45° field of view.
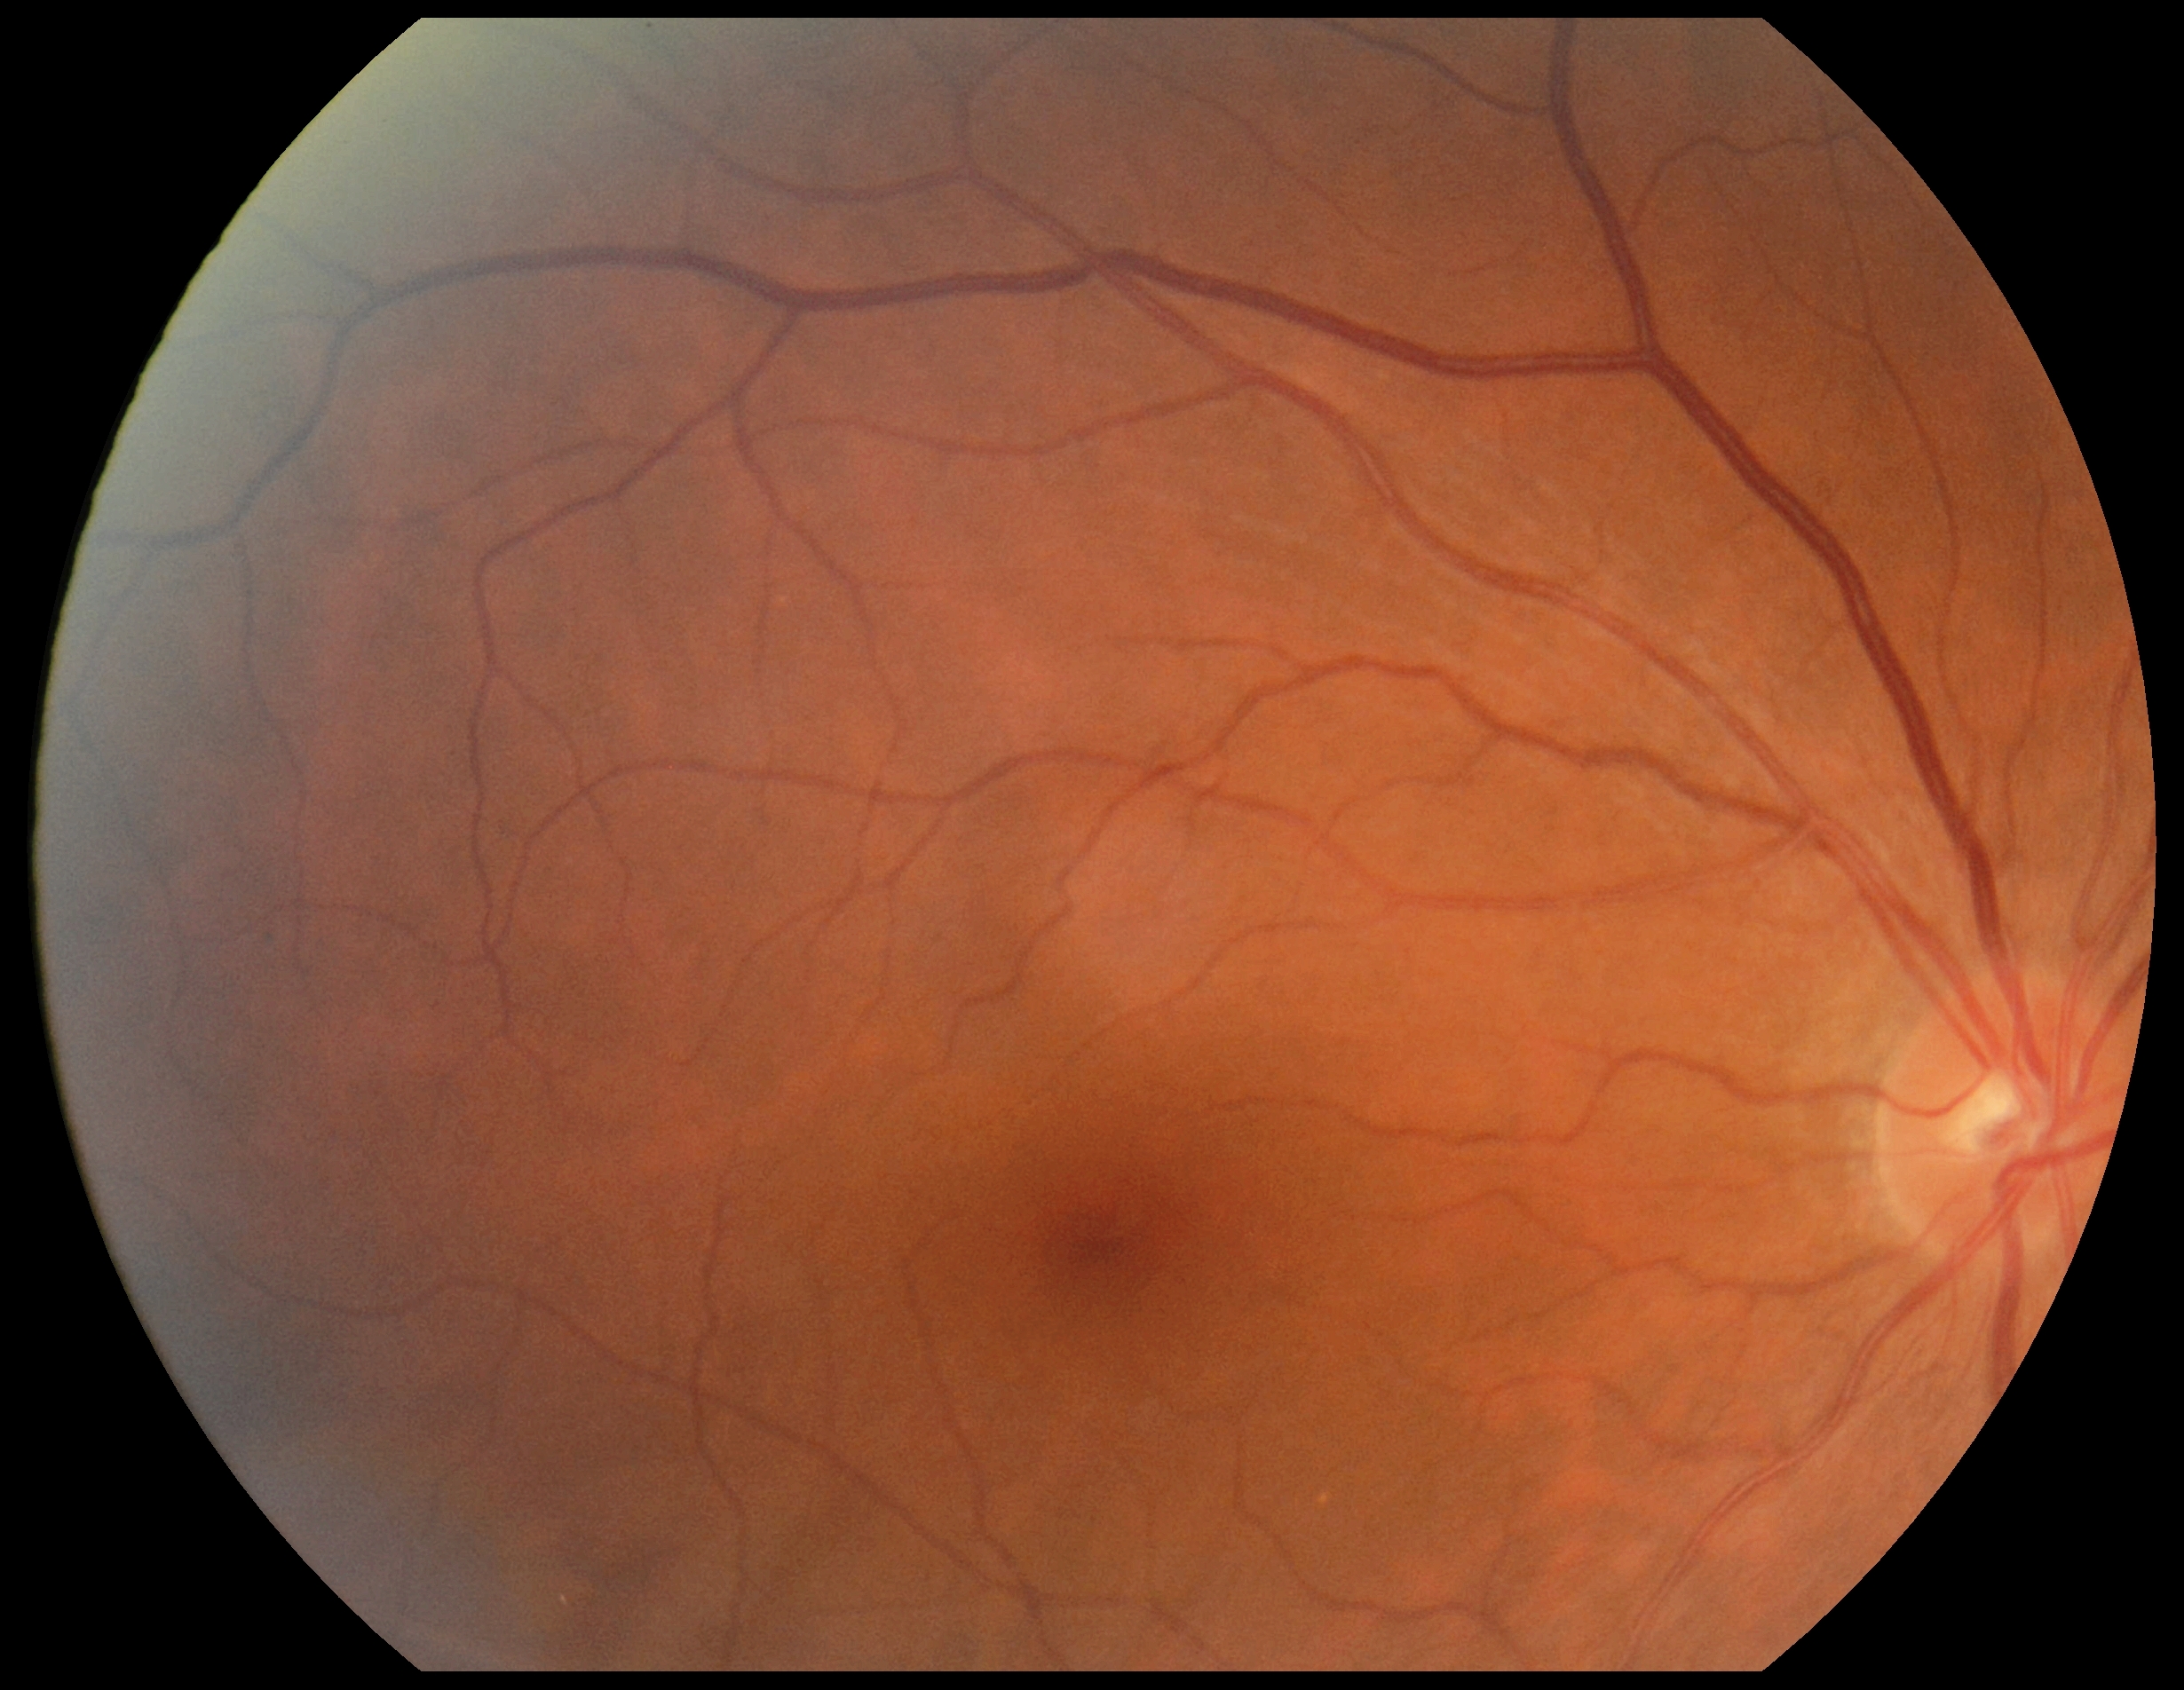 Retinopathy: no apparent diabetic retinopathy (grade 0). No DR findings.